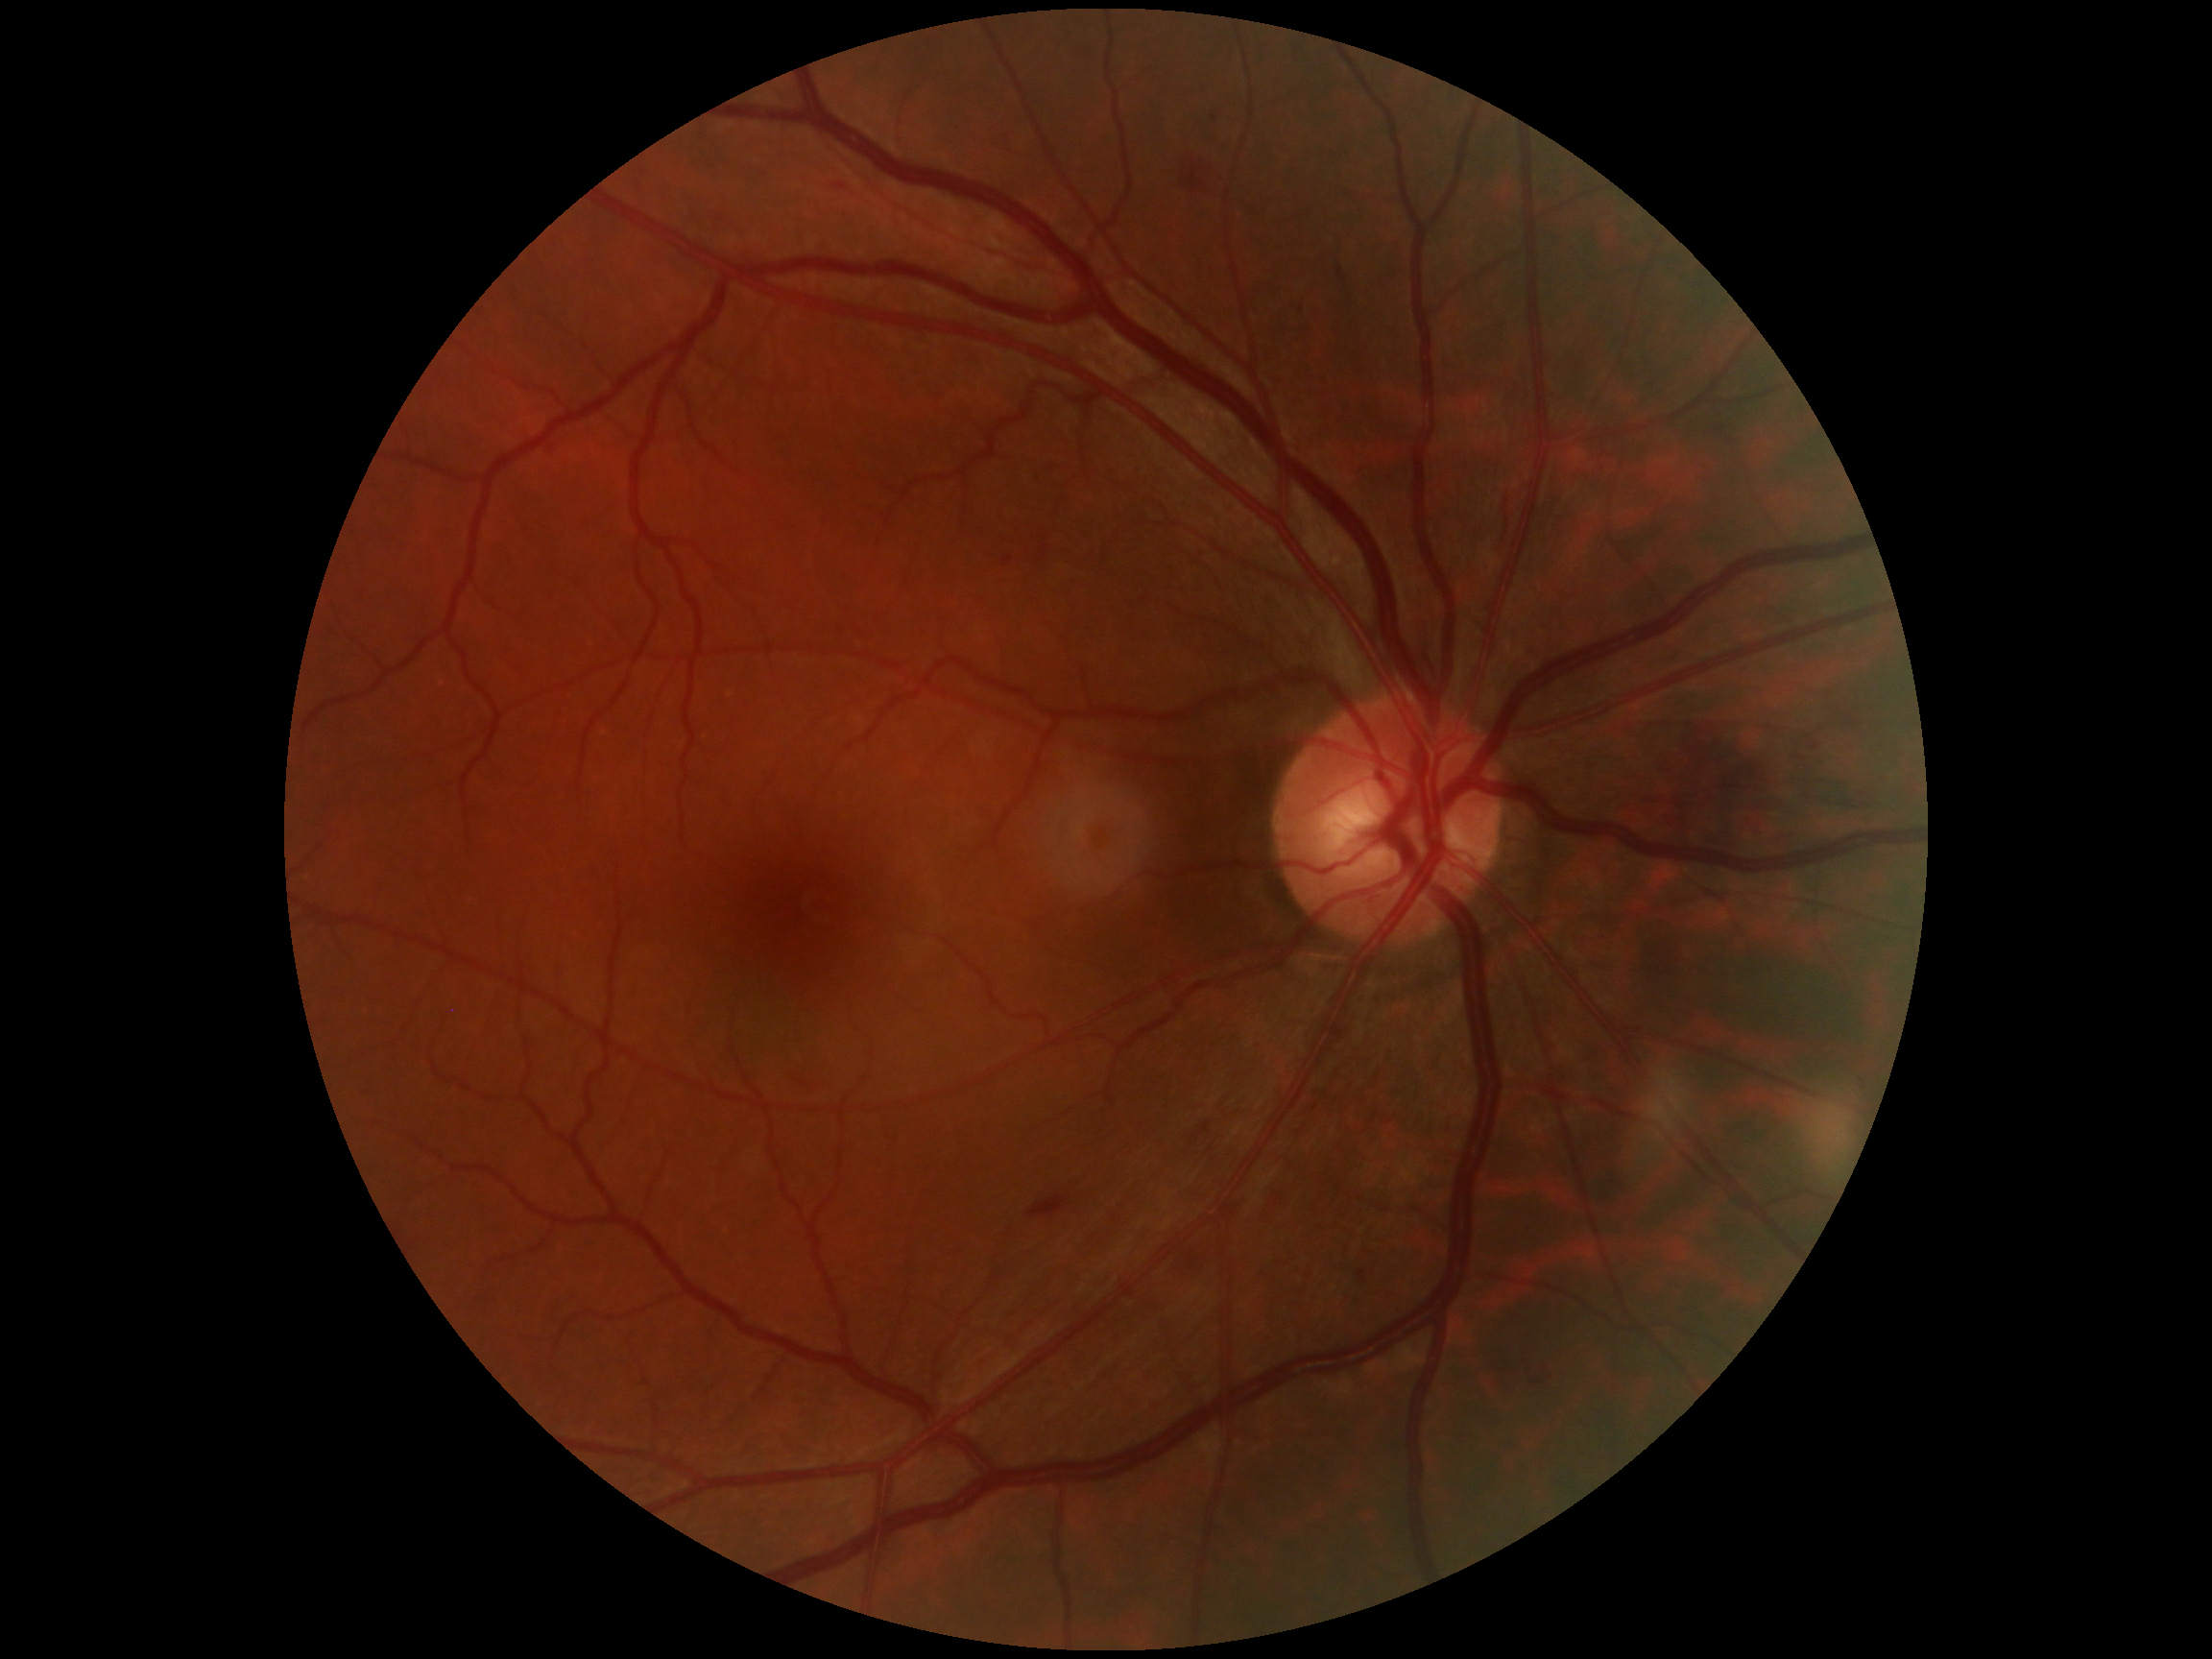

DR grade is moderate NPDR (2).